2184x1690px; 45° field of view.
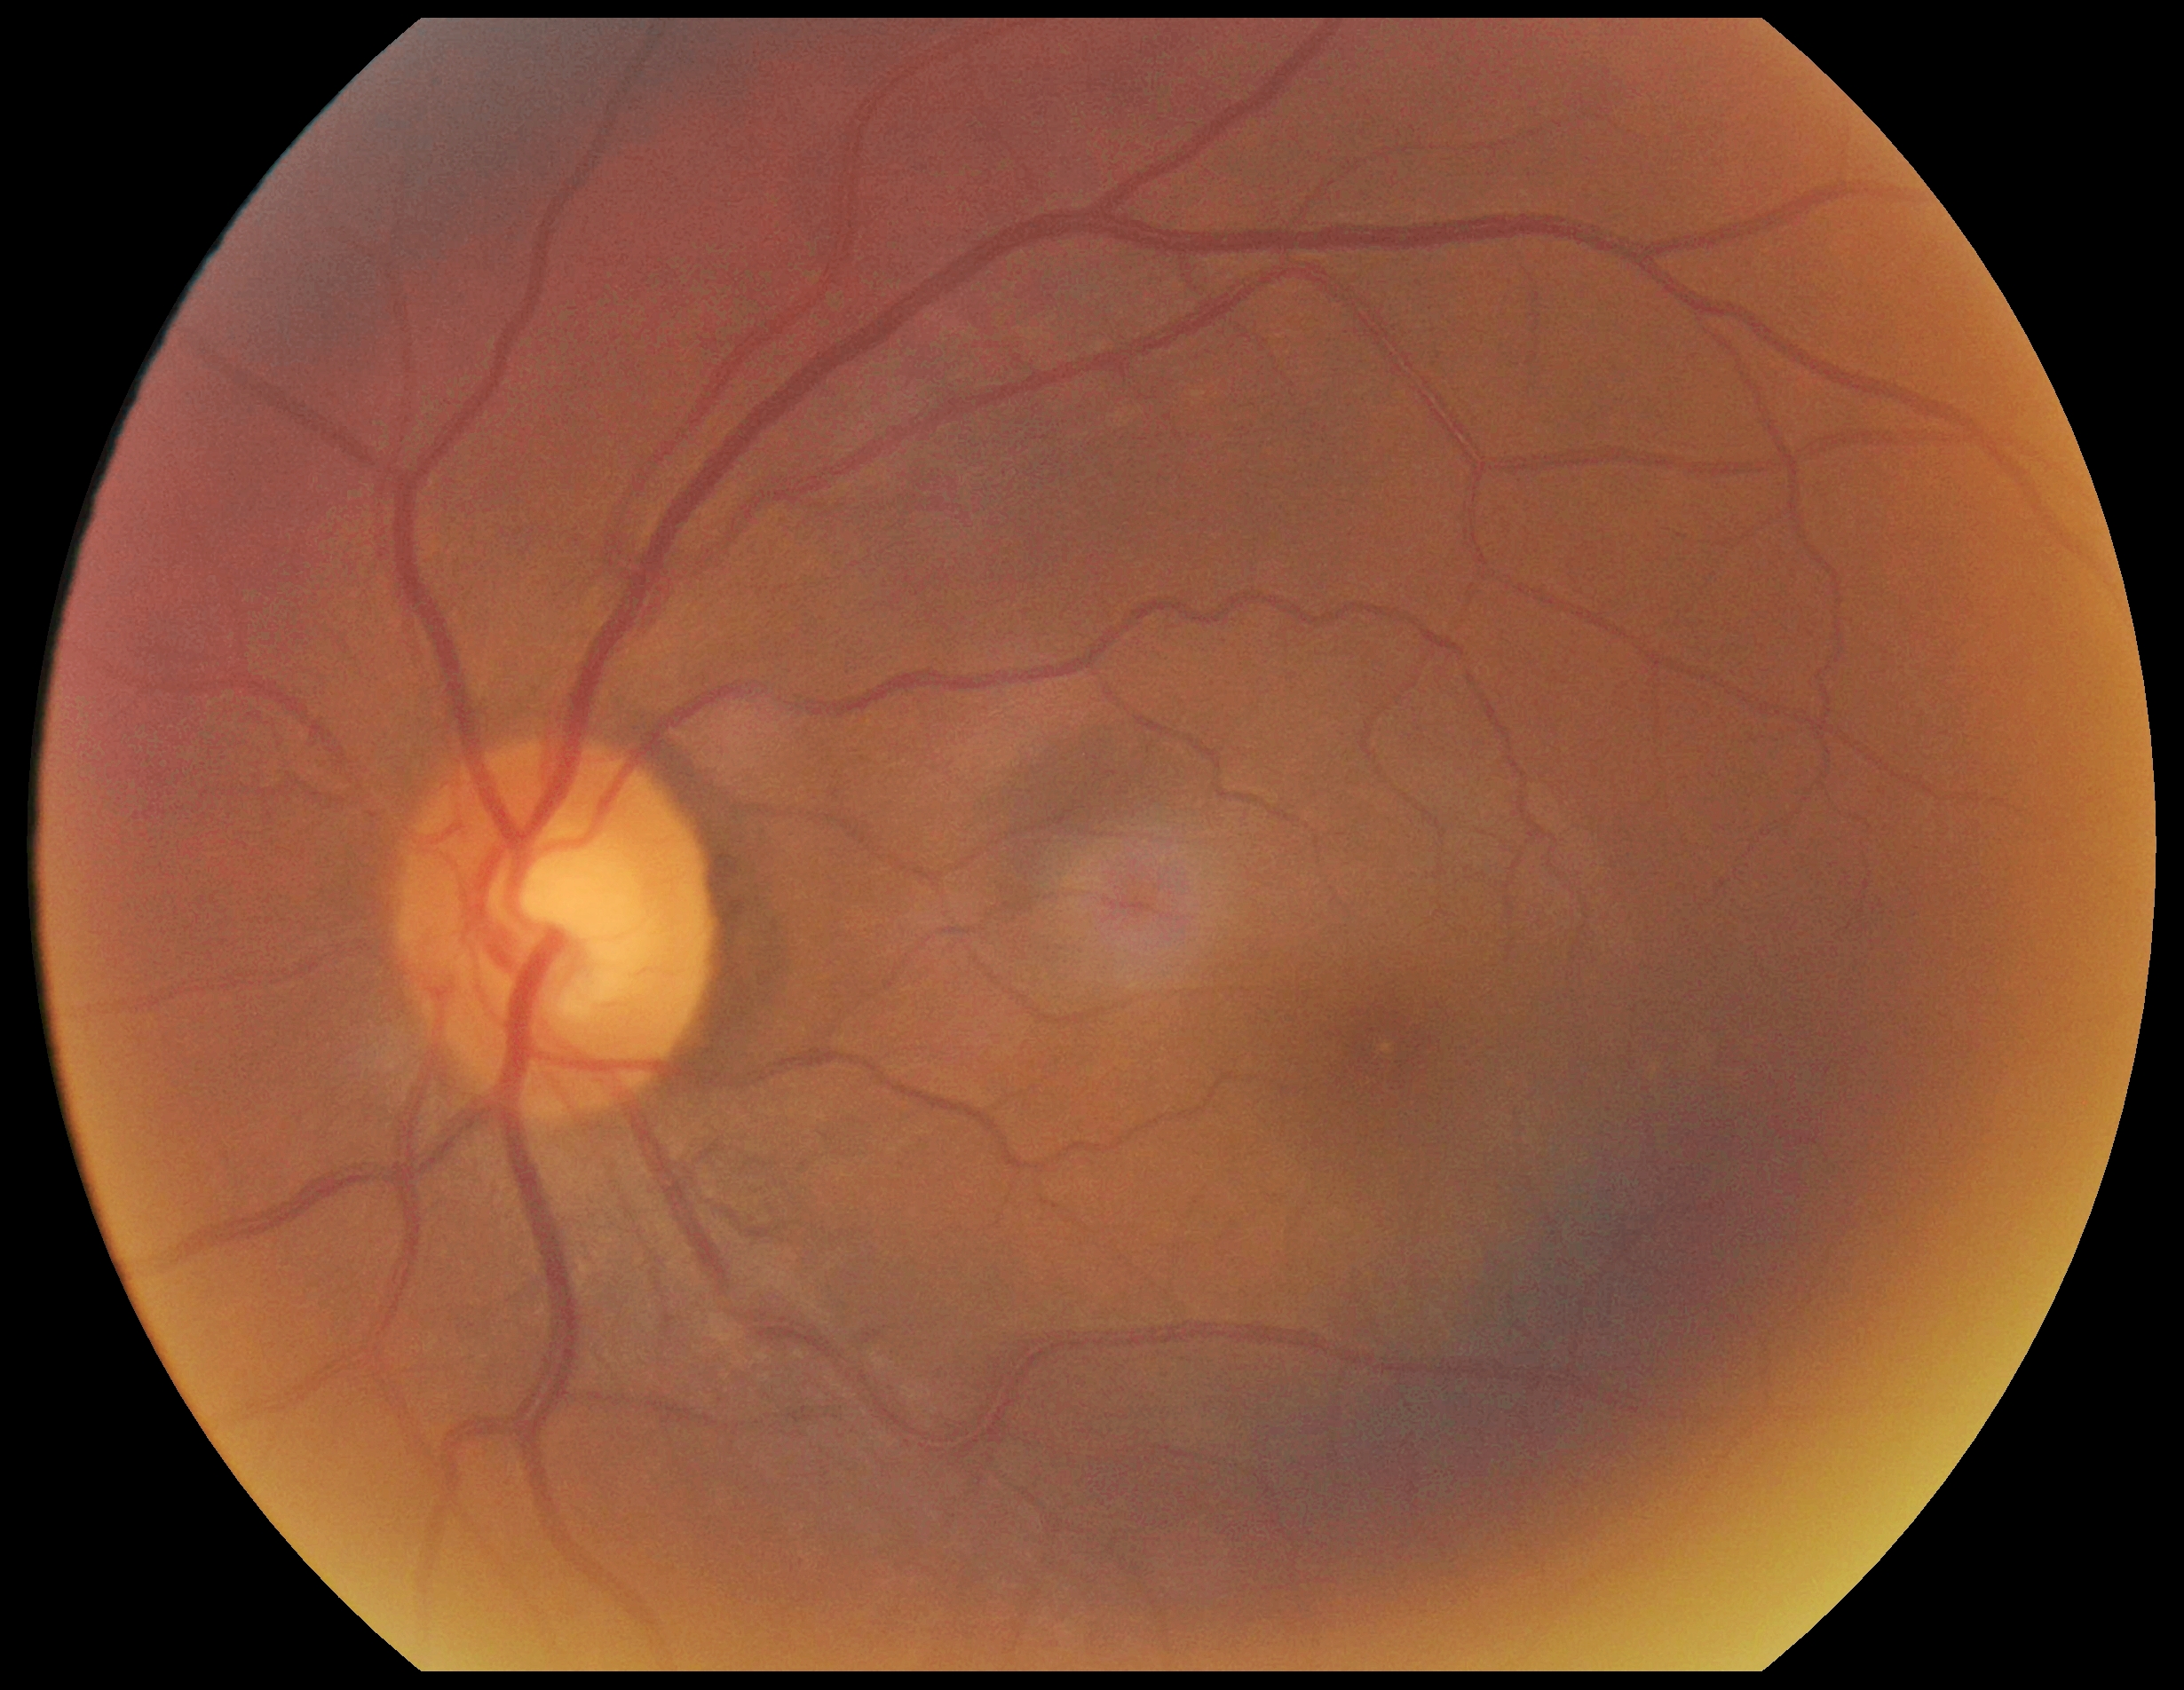

diabetic retinopathy (DR): grade 0.